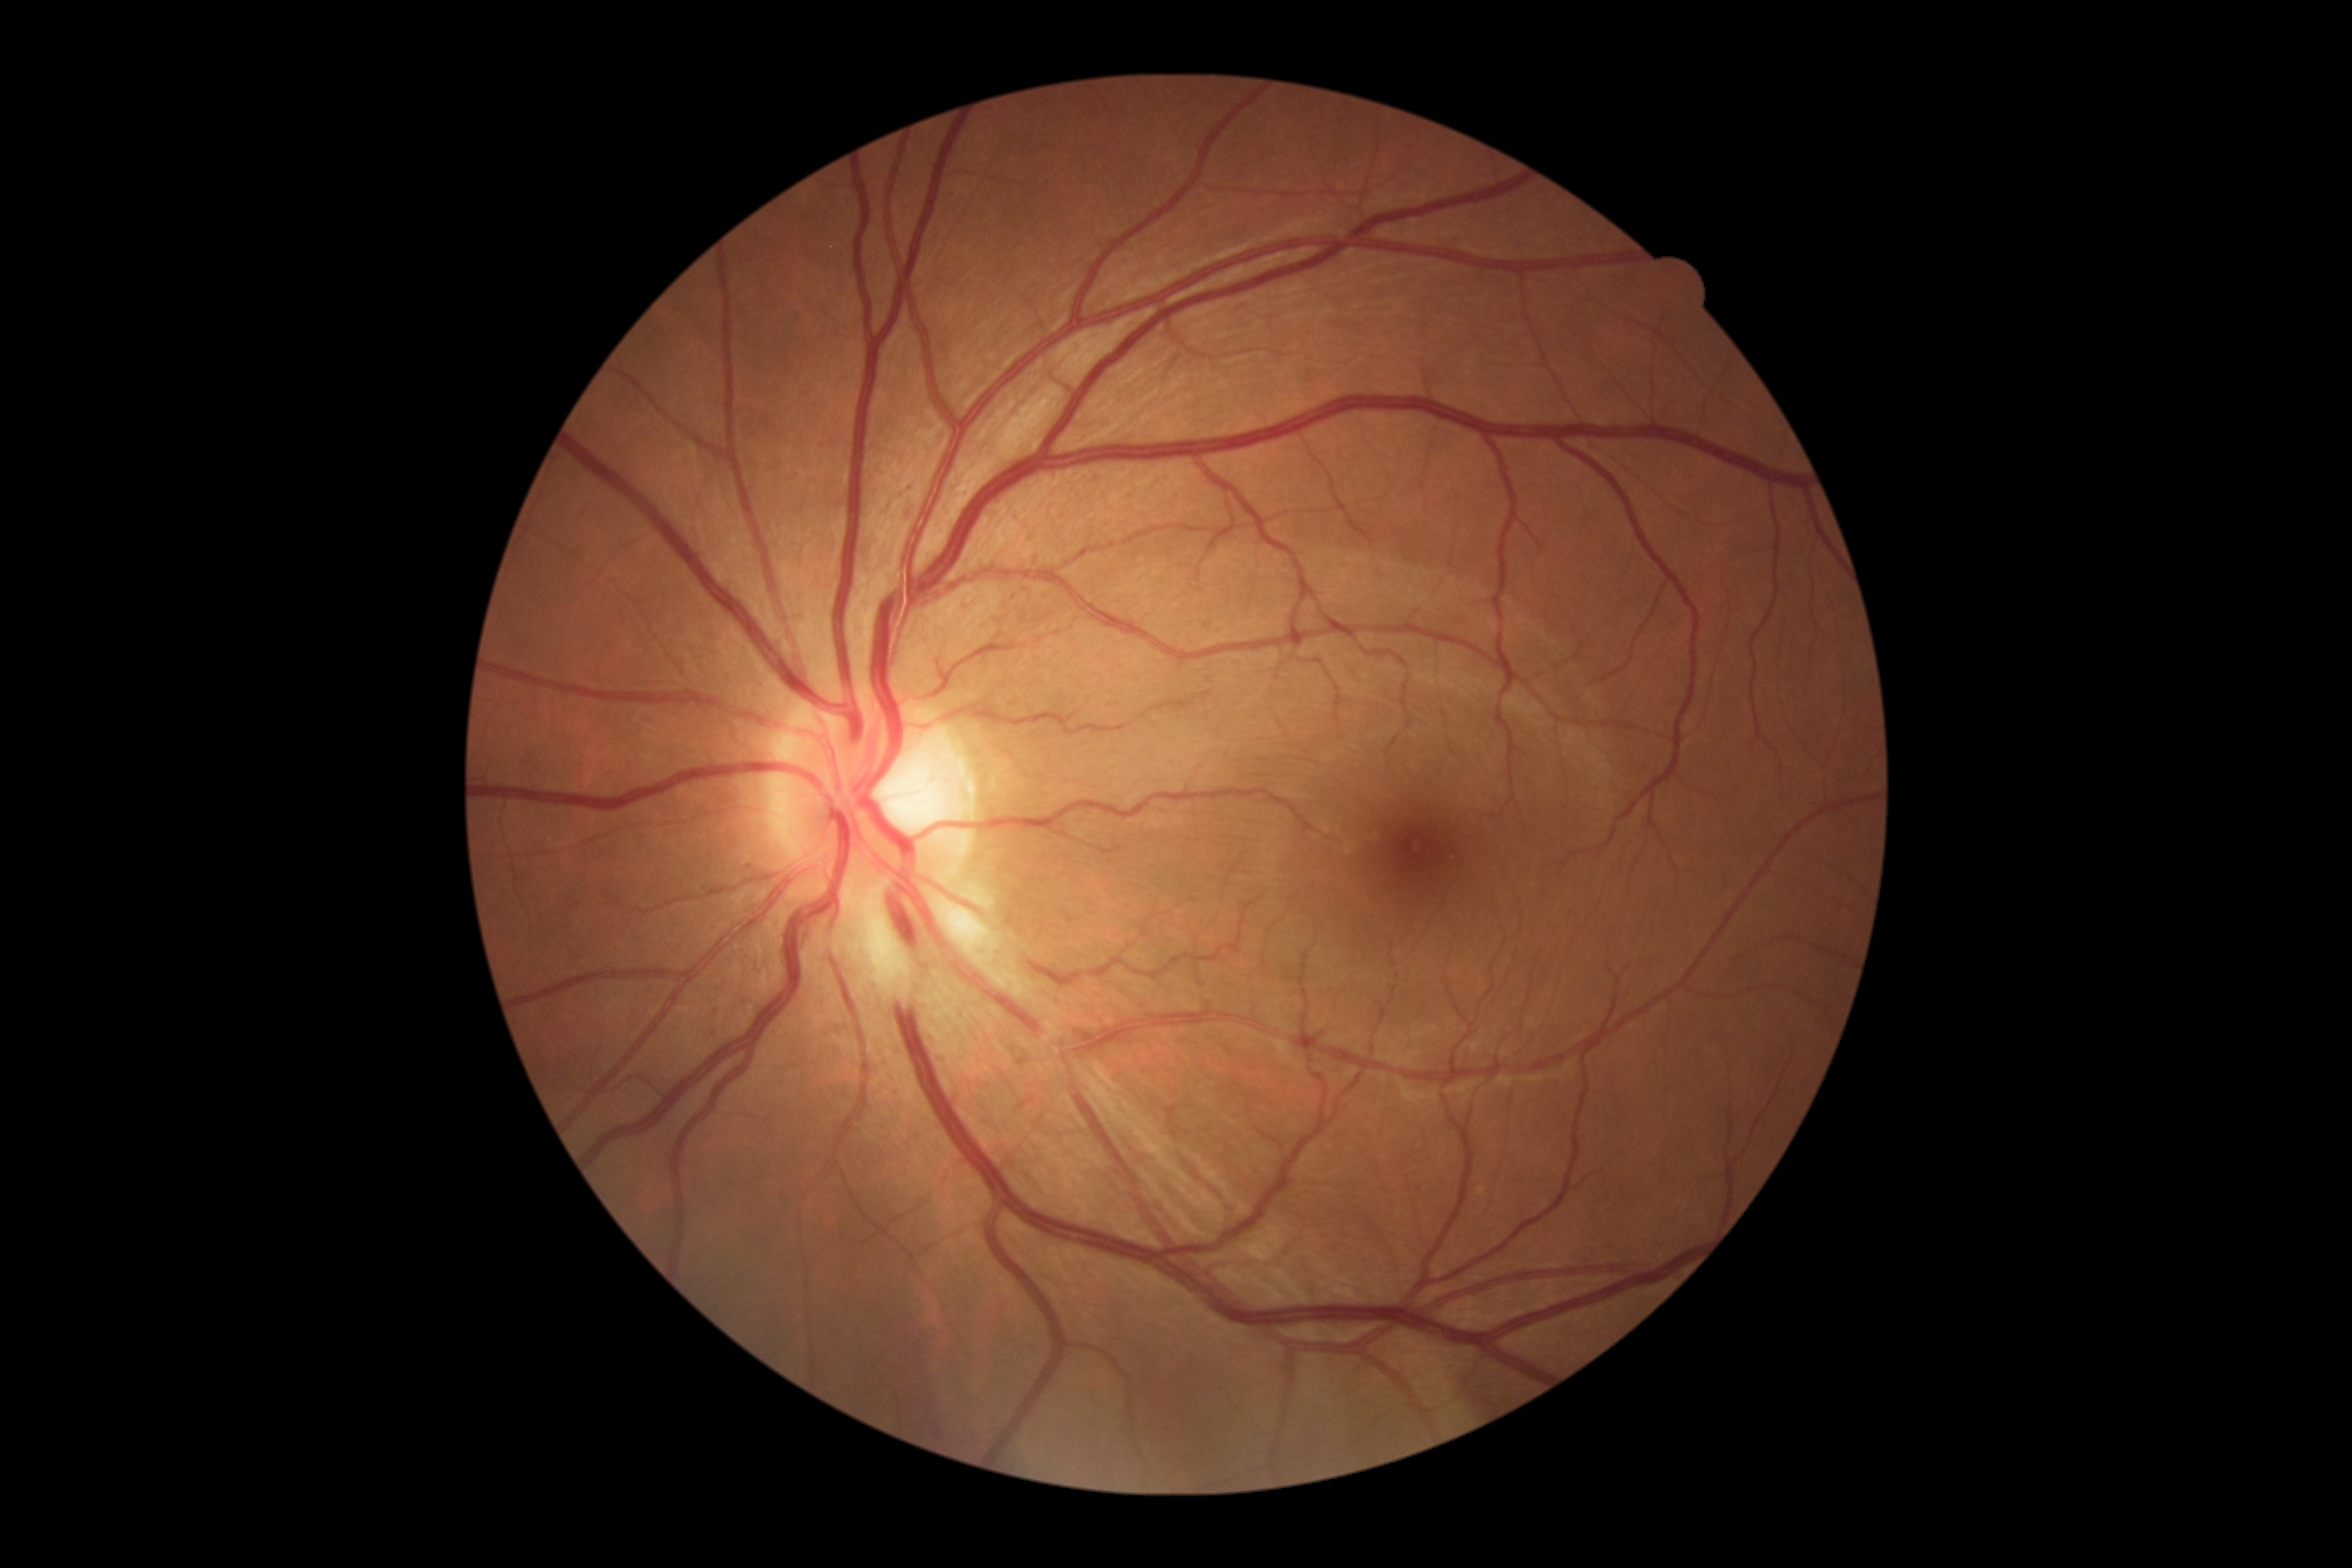 diabetic retinopathy severity: 1/4.